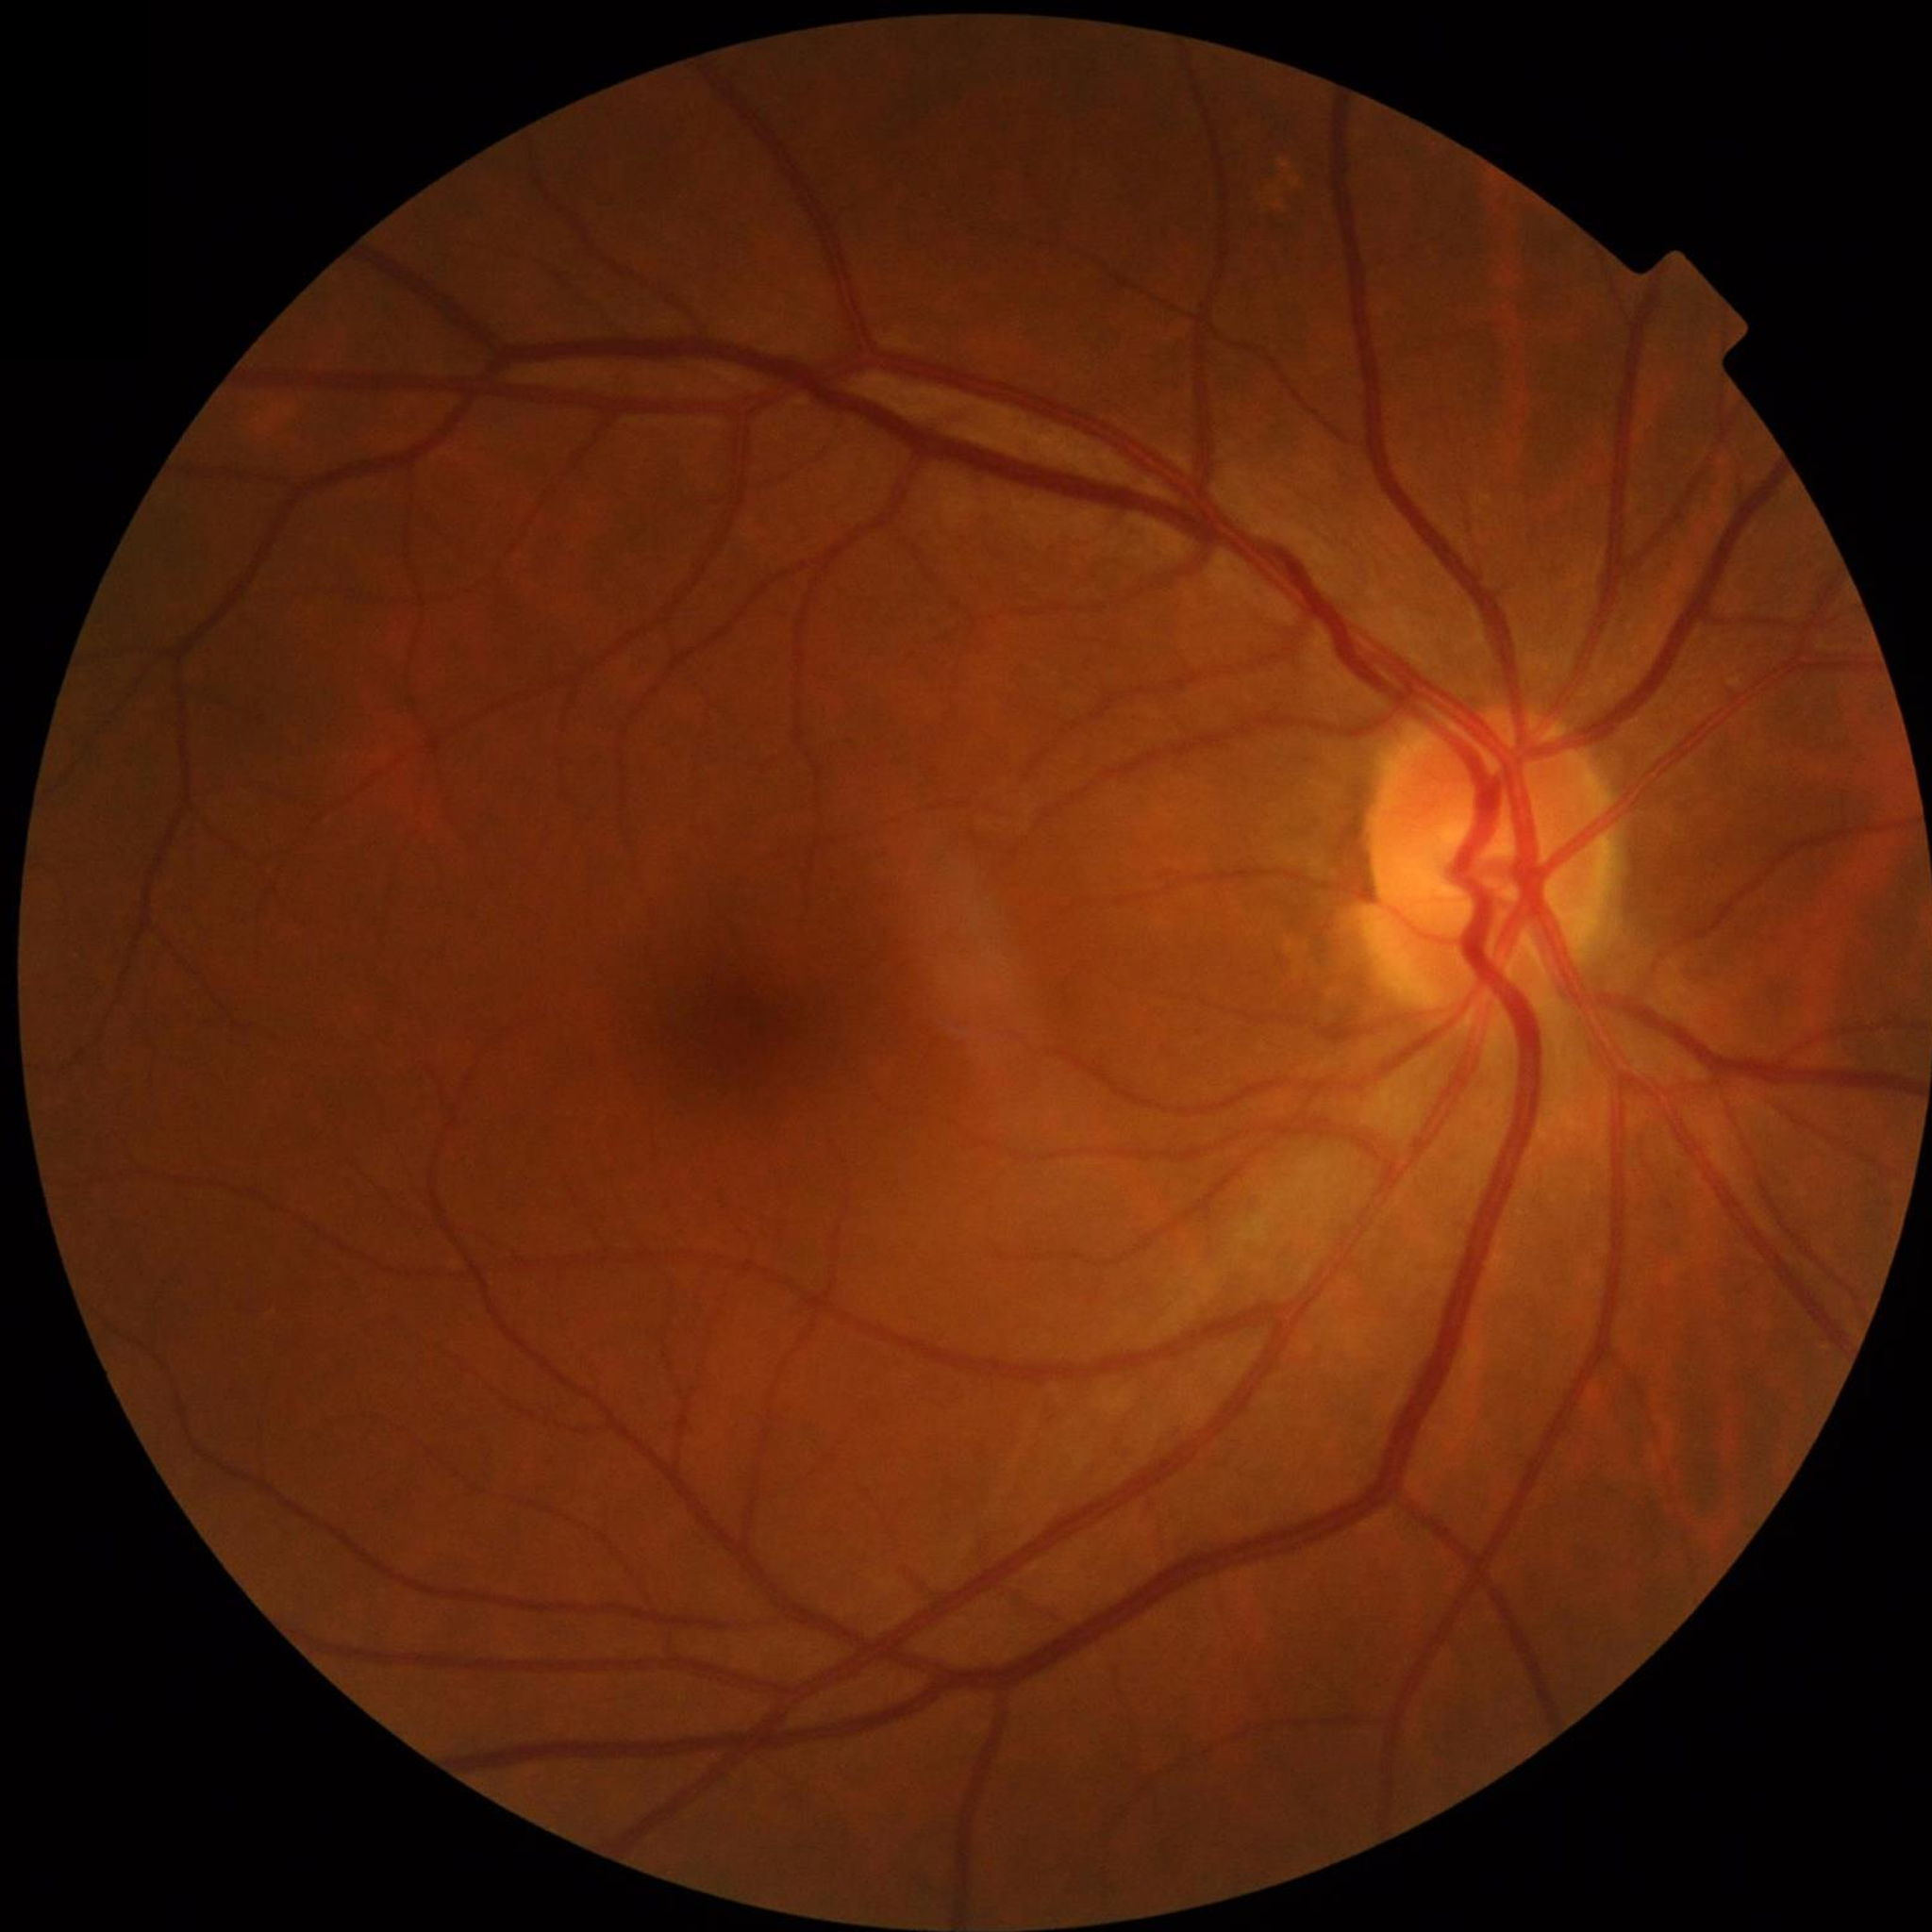
From a control without AMD, diabetic retinopathy, or glaucoma.